Wide-field contact fundus photograph of an infant. 640x480px: 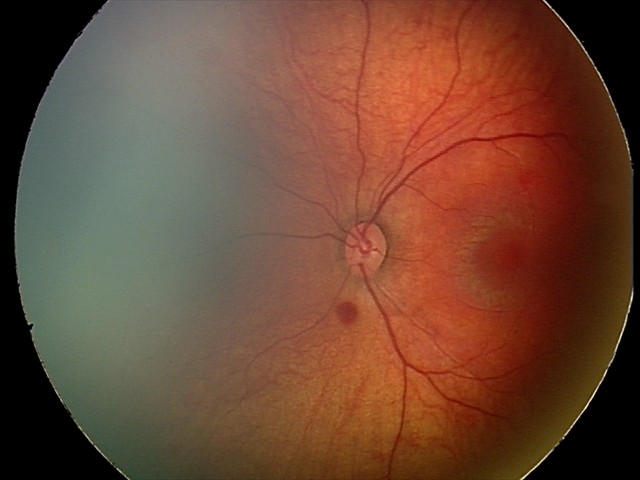
Diagnosis from this screening exam: retinal hemorrhages.